Wide-field contact fundus photograph of an infant — 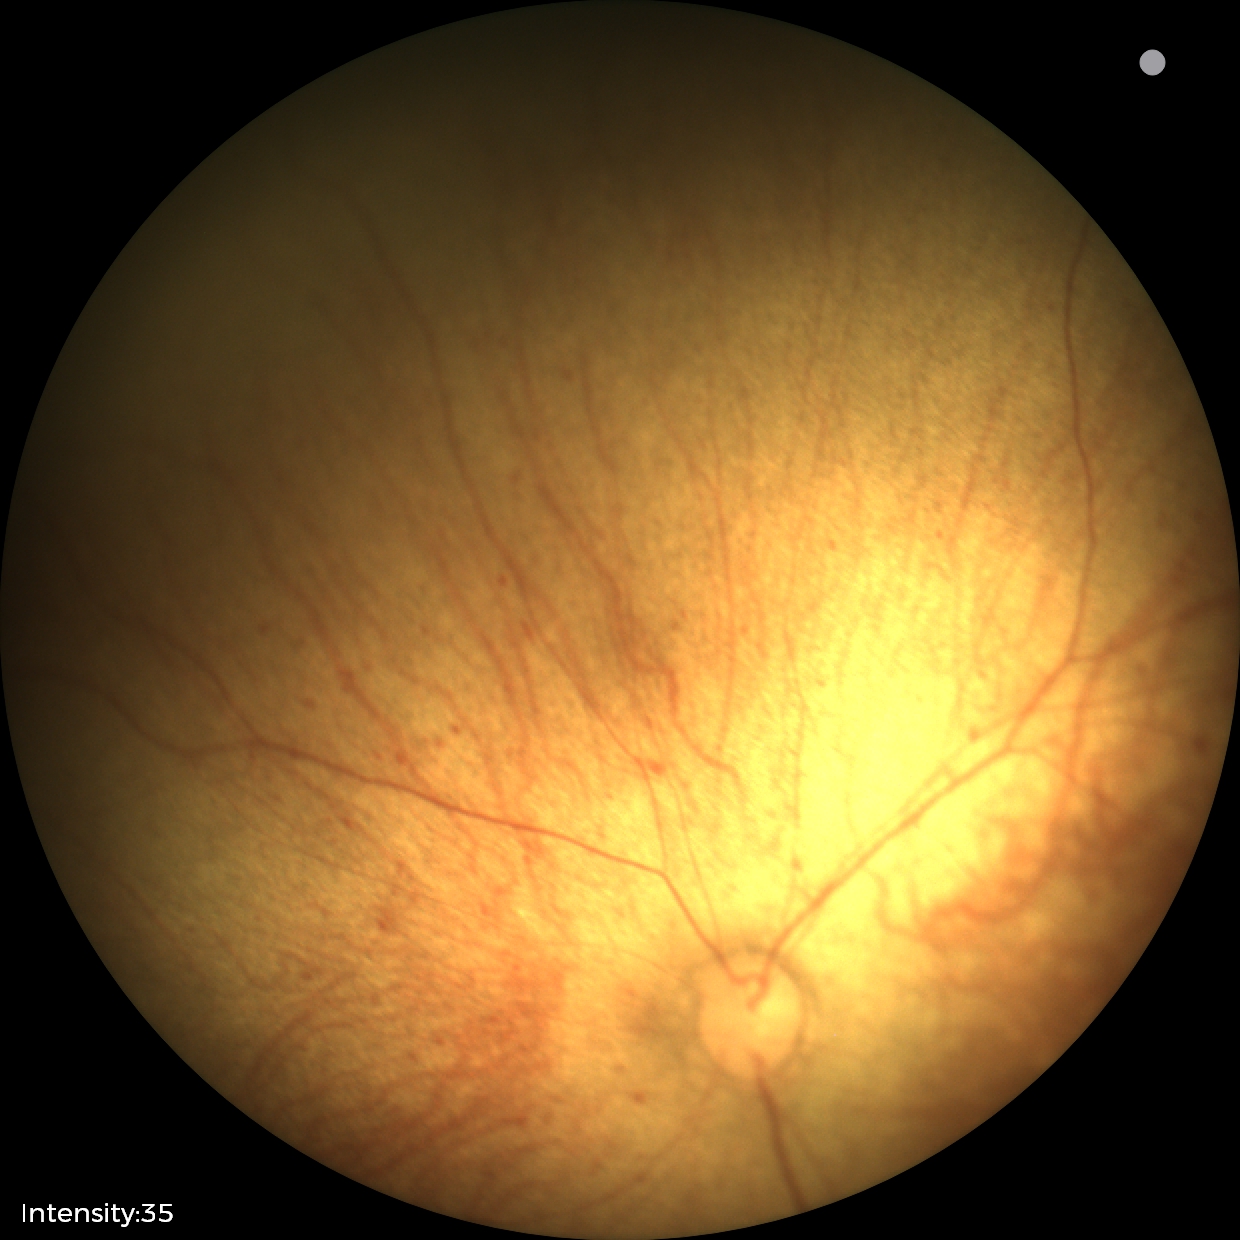

Physiological retinal appearance for postconceptual age.